Optic disc-centered crop.
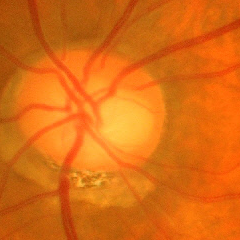
Demonstrates advanced glaucomatous optic neuropathy.